2352x1568. 45° FOV: 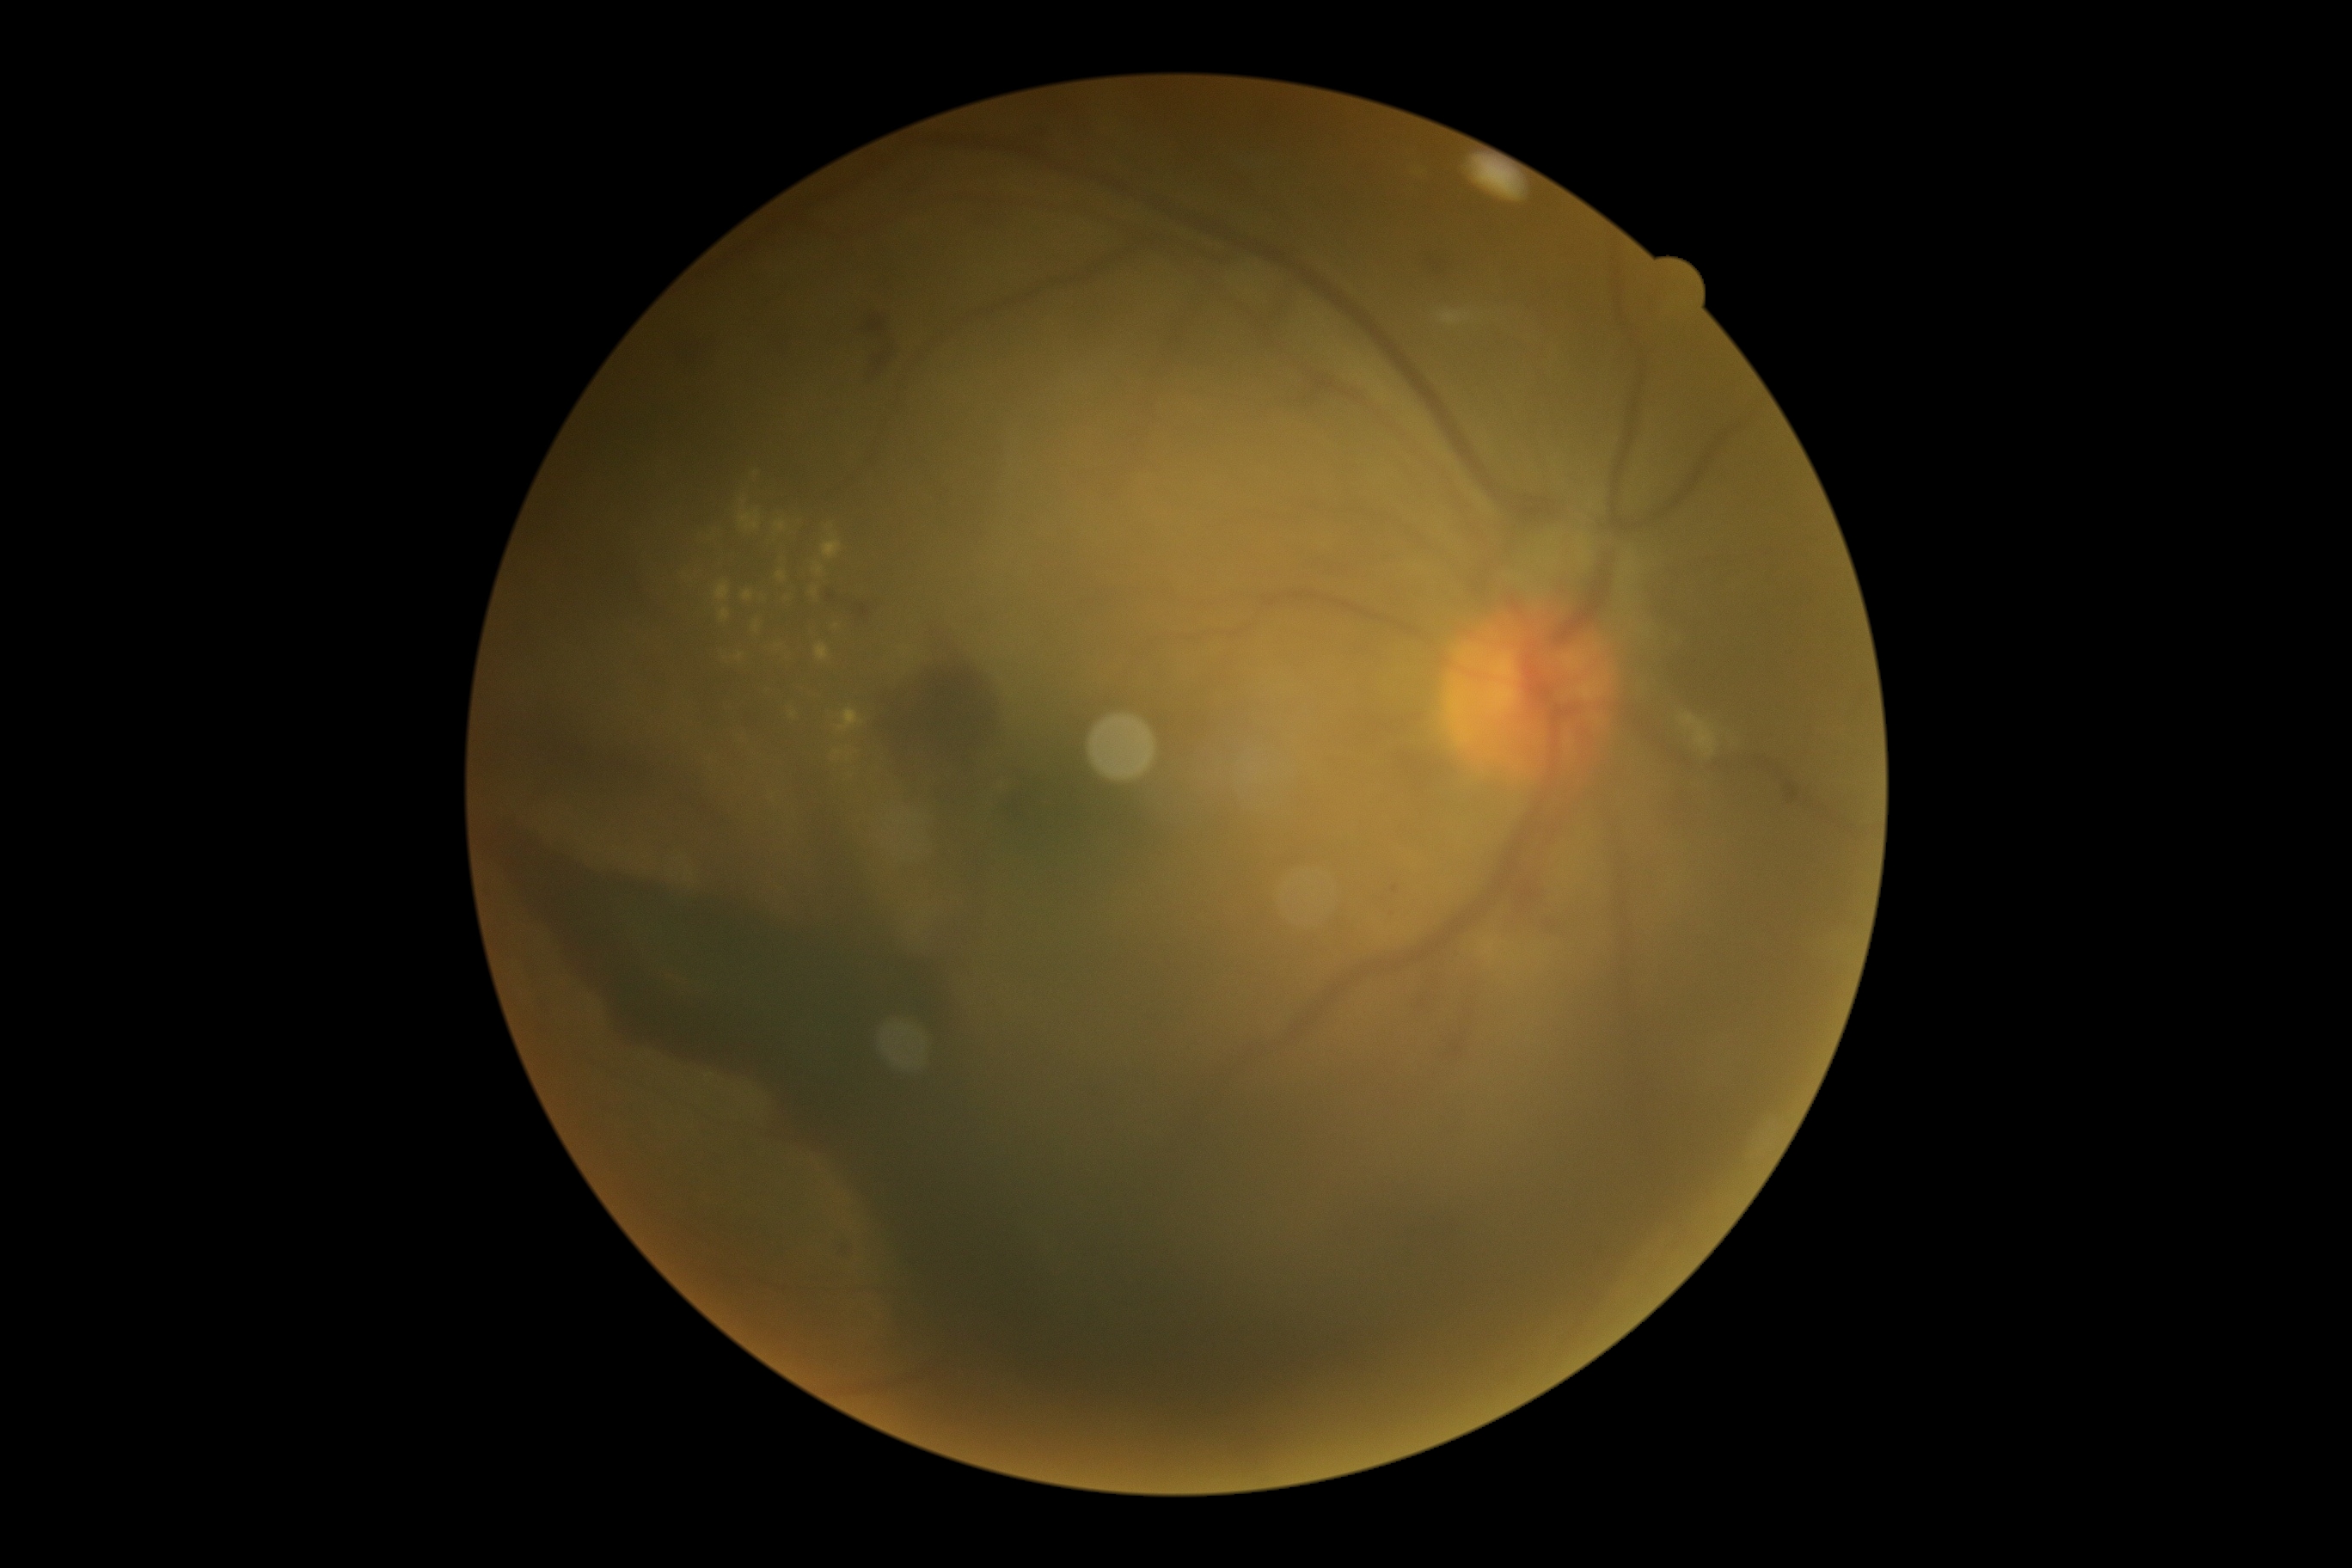

{
  "dr_grade": "grade 4 (PDR)"
}